2228x1652 · central posterior field · mydriatic (tropicamide and phenylephrine) · captured on a Topcon TRC-50DX fundus camera — 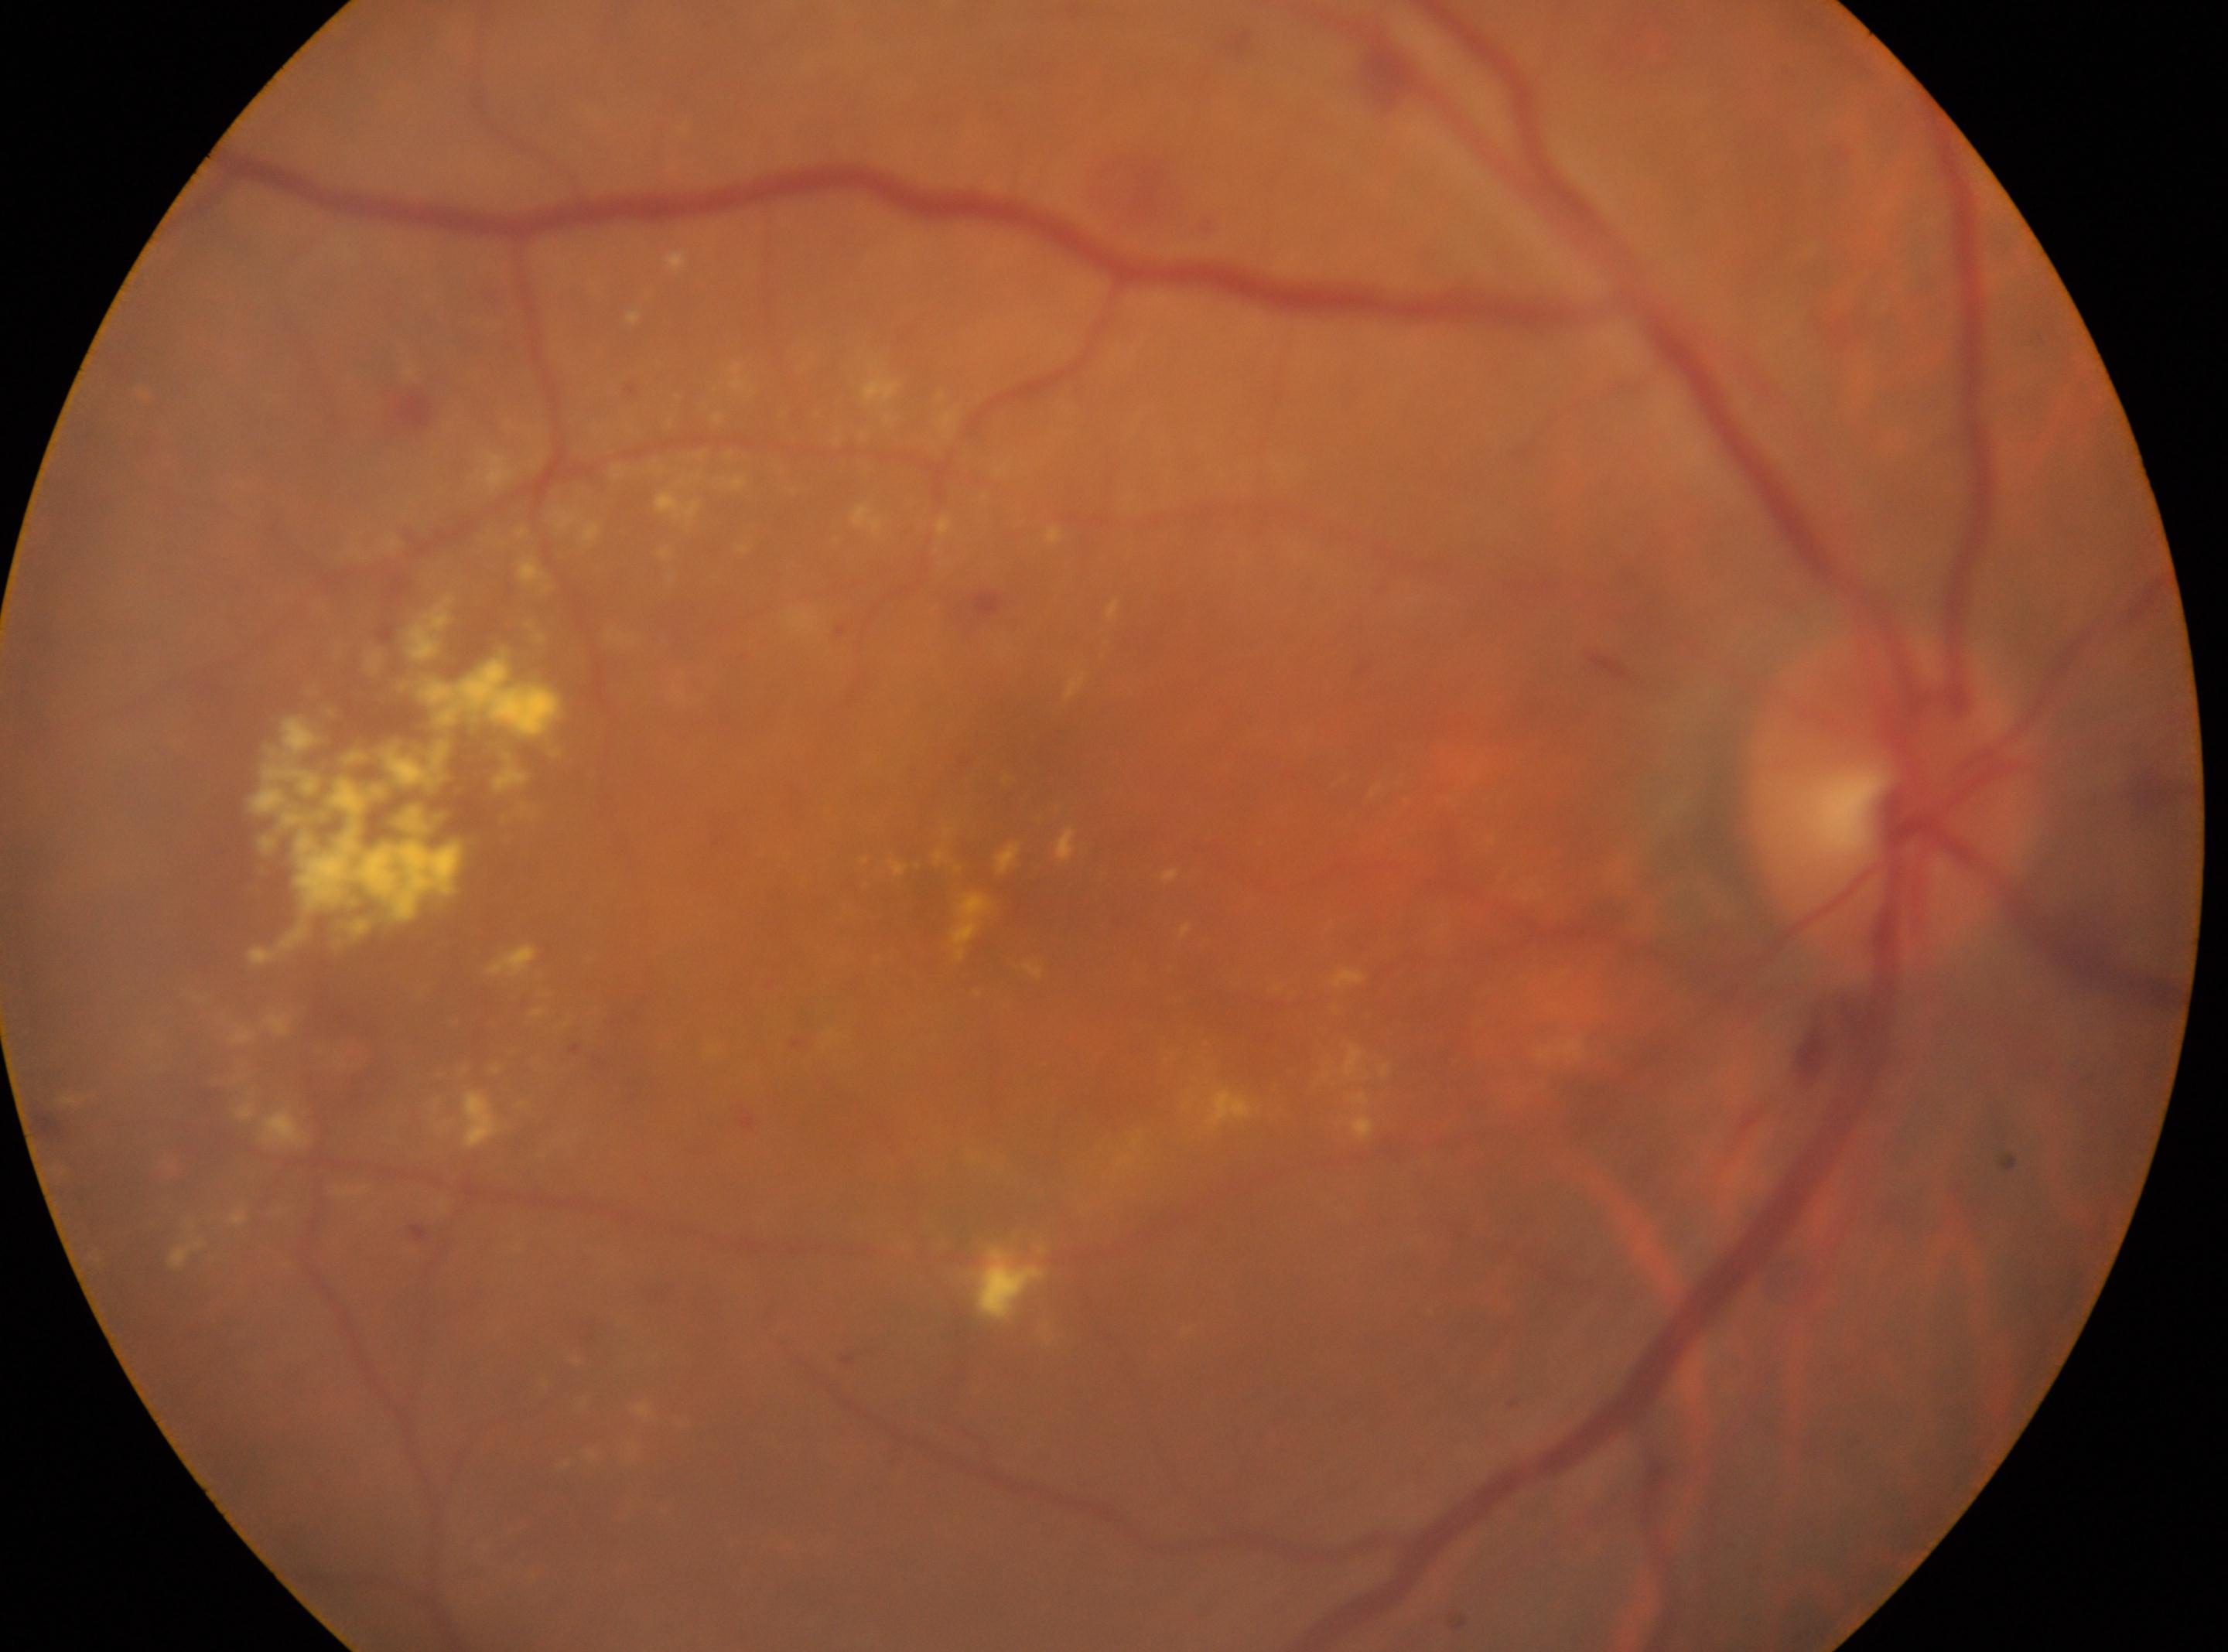 Diabetic retinopathy (DR): grade 2 (moderate NPDR). Eye: right. Macula center: 1027px, 871px. Optic disk: 1886px, 800px.